1240x1240px. Phoenix ICON, 100° FOV. Phoenix ICON wide-field infant fundus image
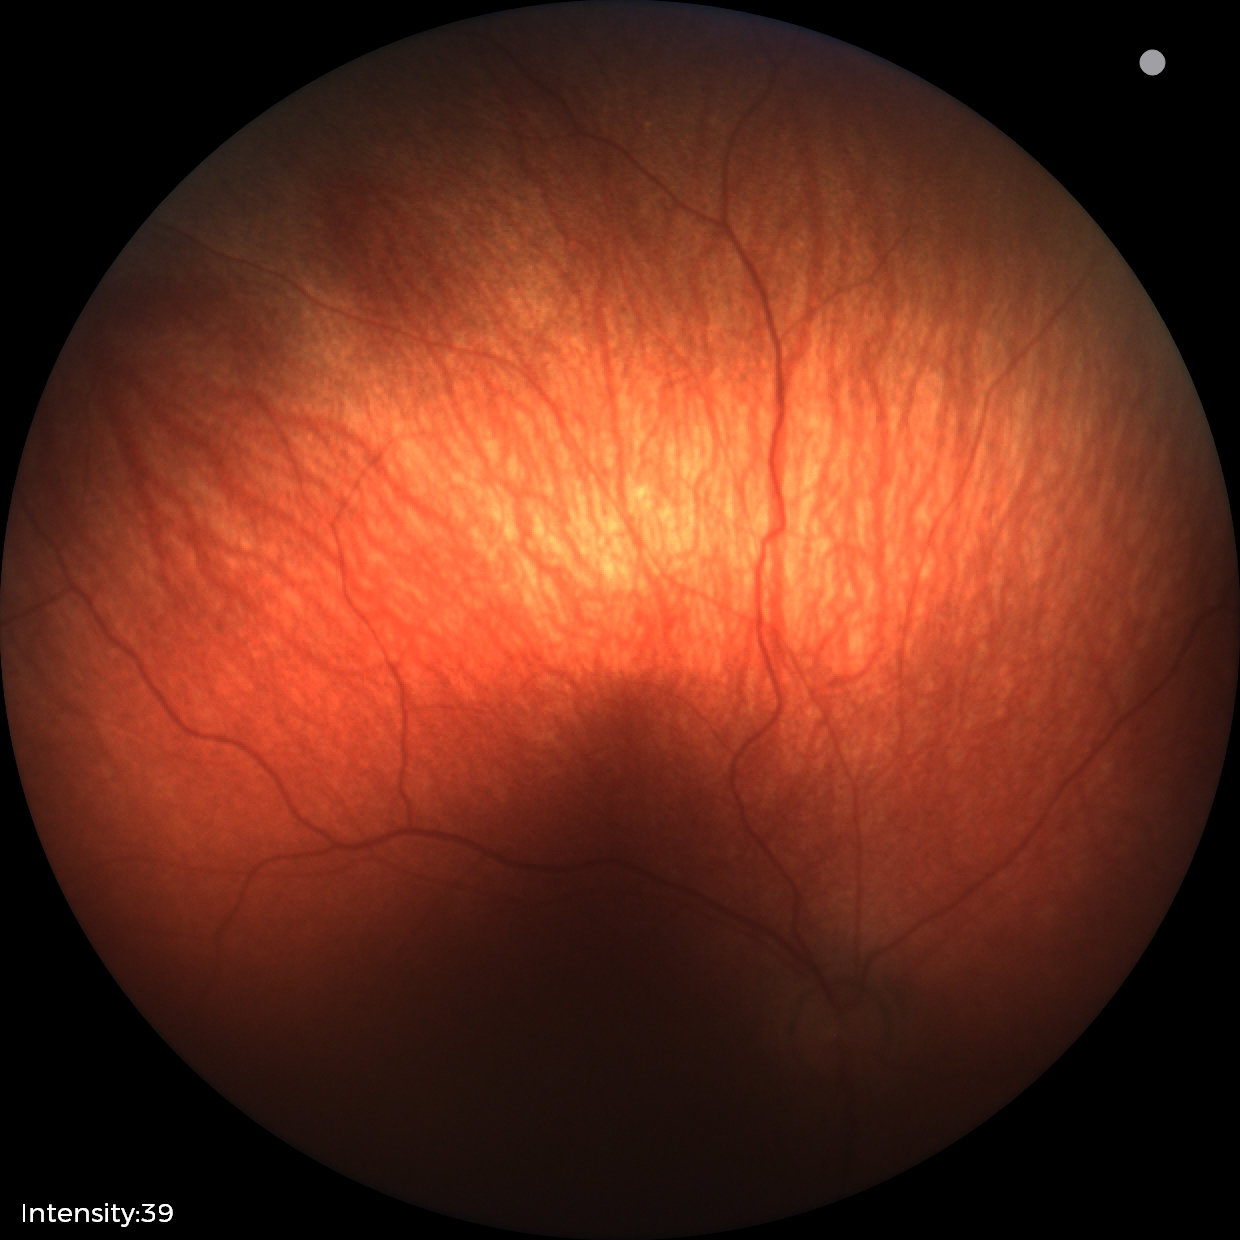

Screening examination with no abnormal retinal findings.